Wide-field contact fundus photograph of an infant:
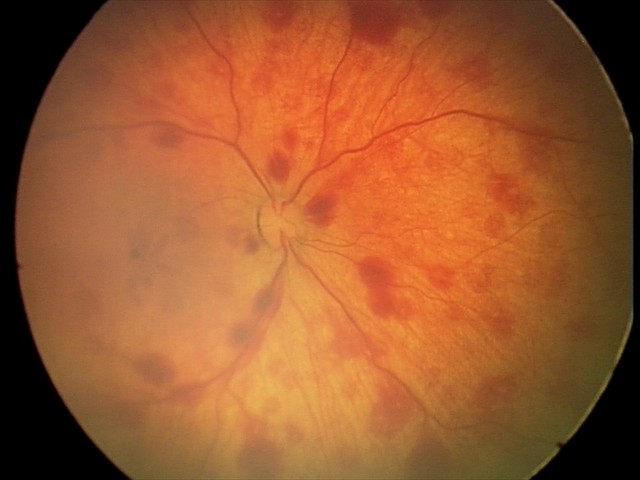

Finding: retinal hemorrhages